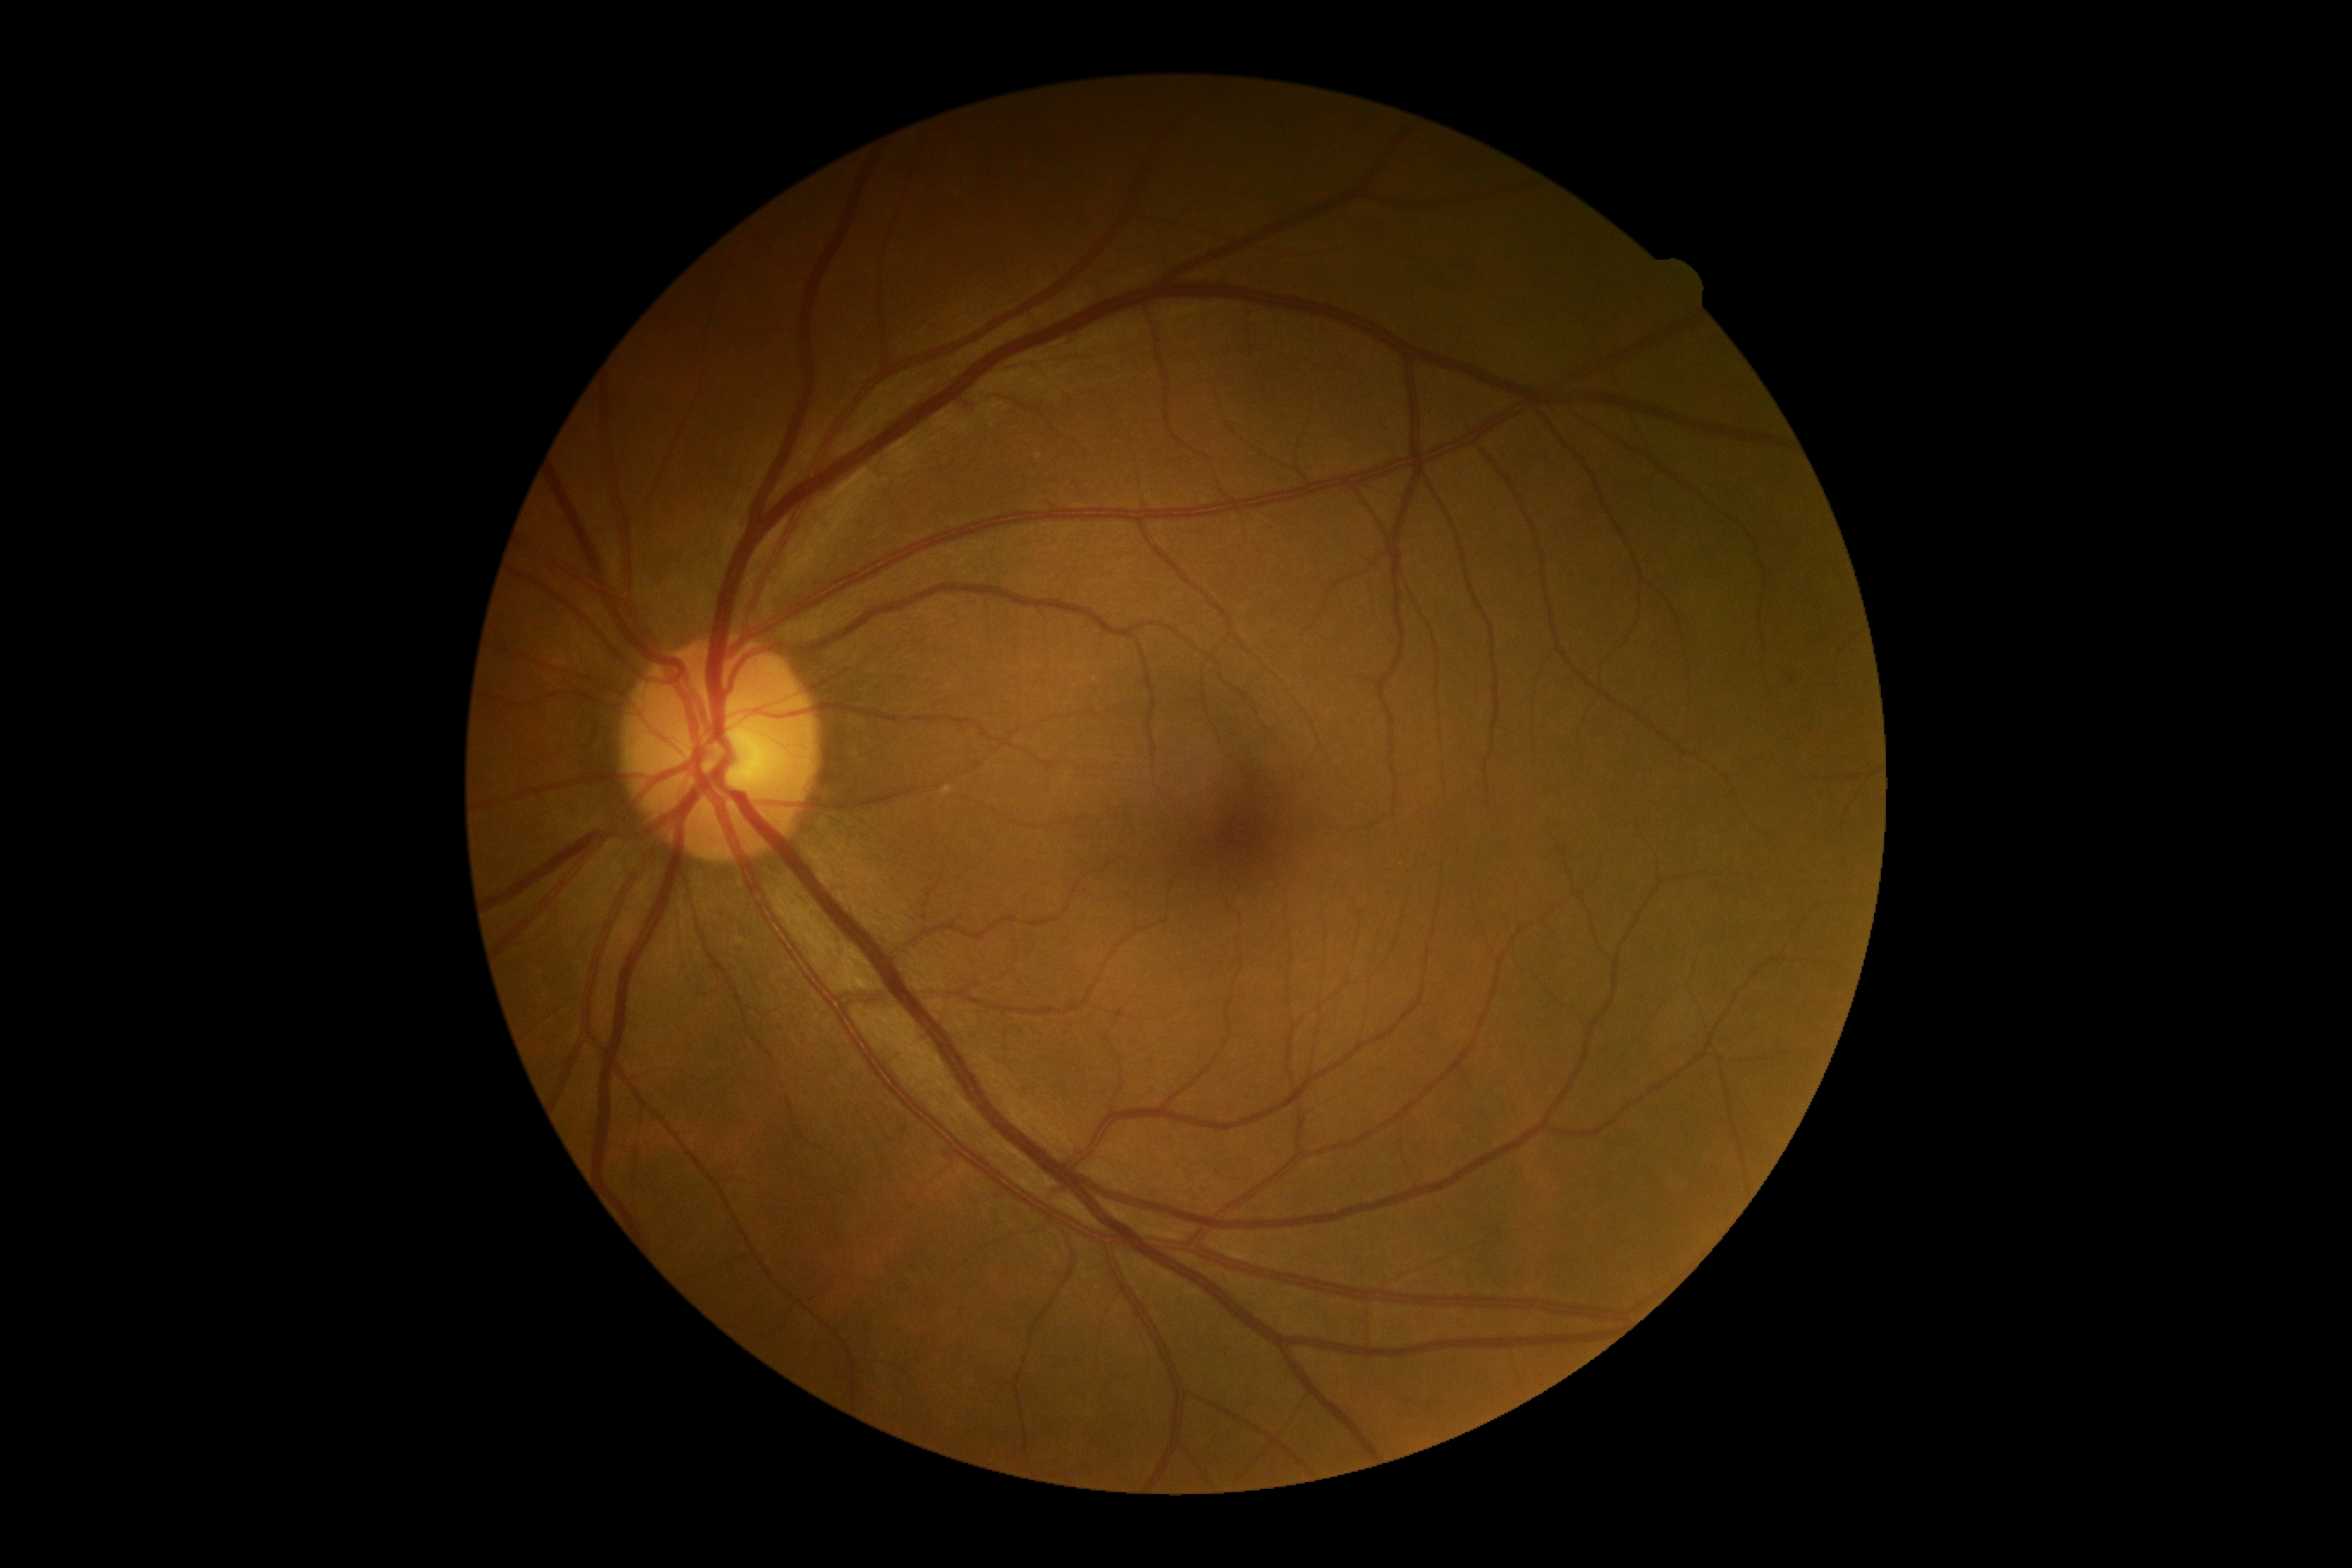

DR=no apparent retinopathy (grade 0) — no visible signs of diabetic retinopathy.